Without pupil dilation — 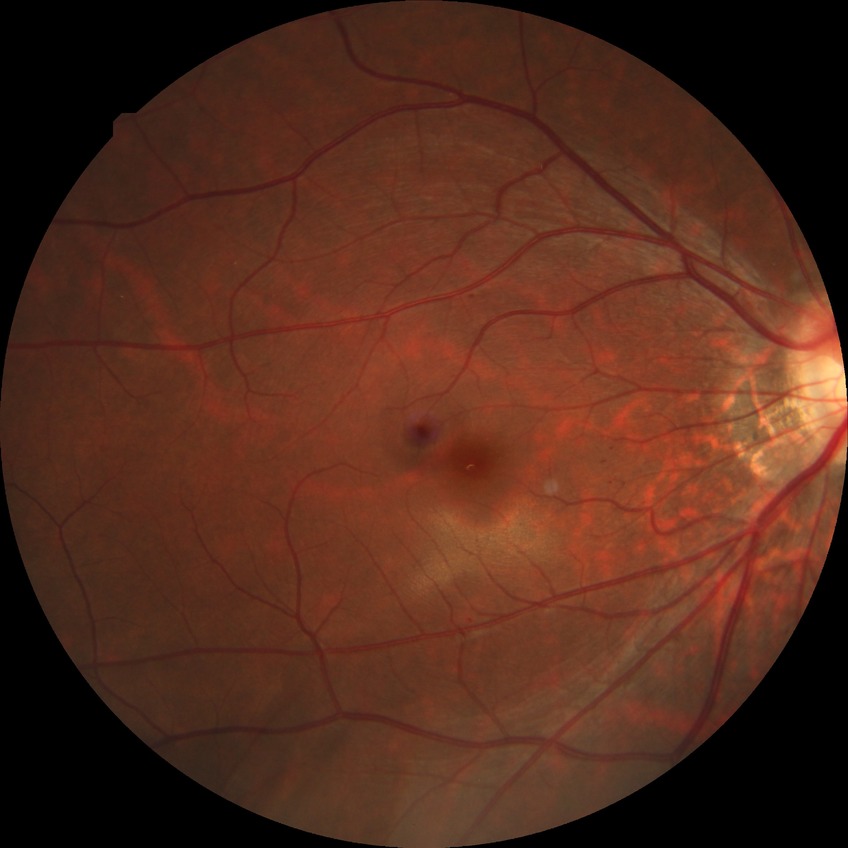
Retinopathy grade is simple diabetic retinopathy.